2352 by 1568 pixels — 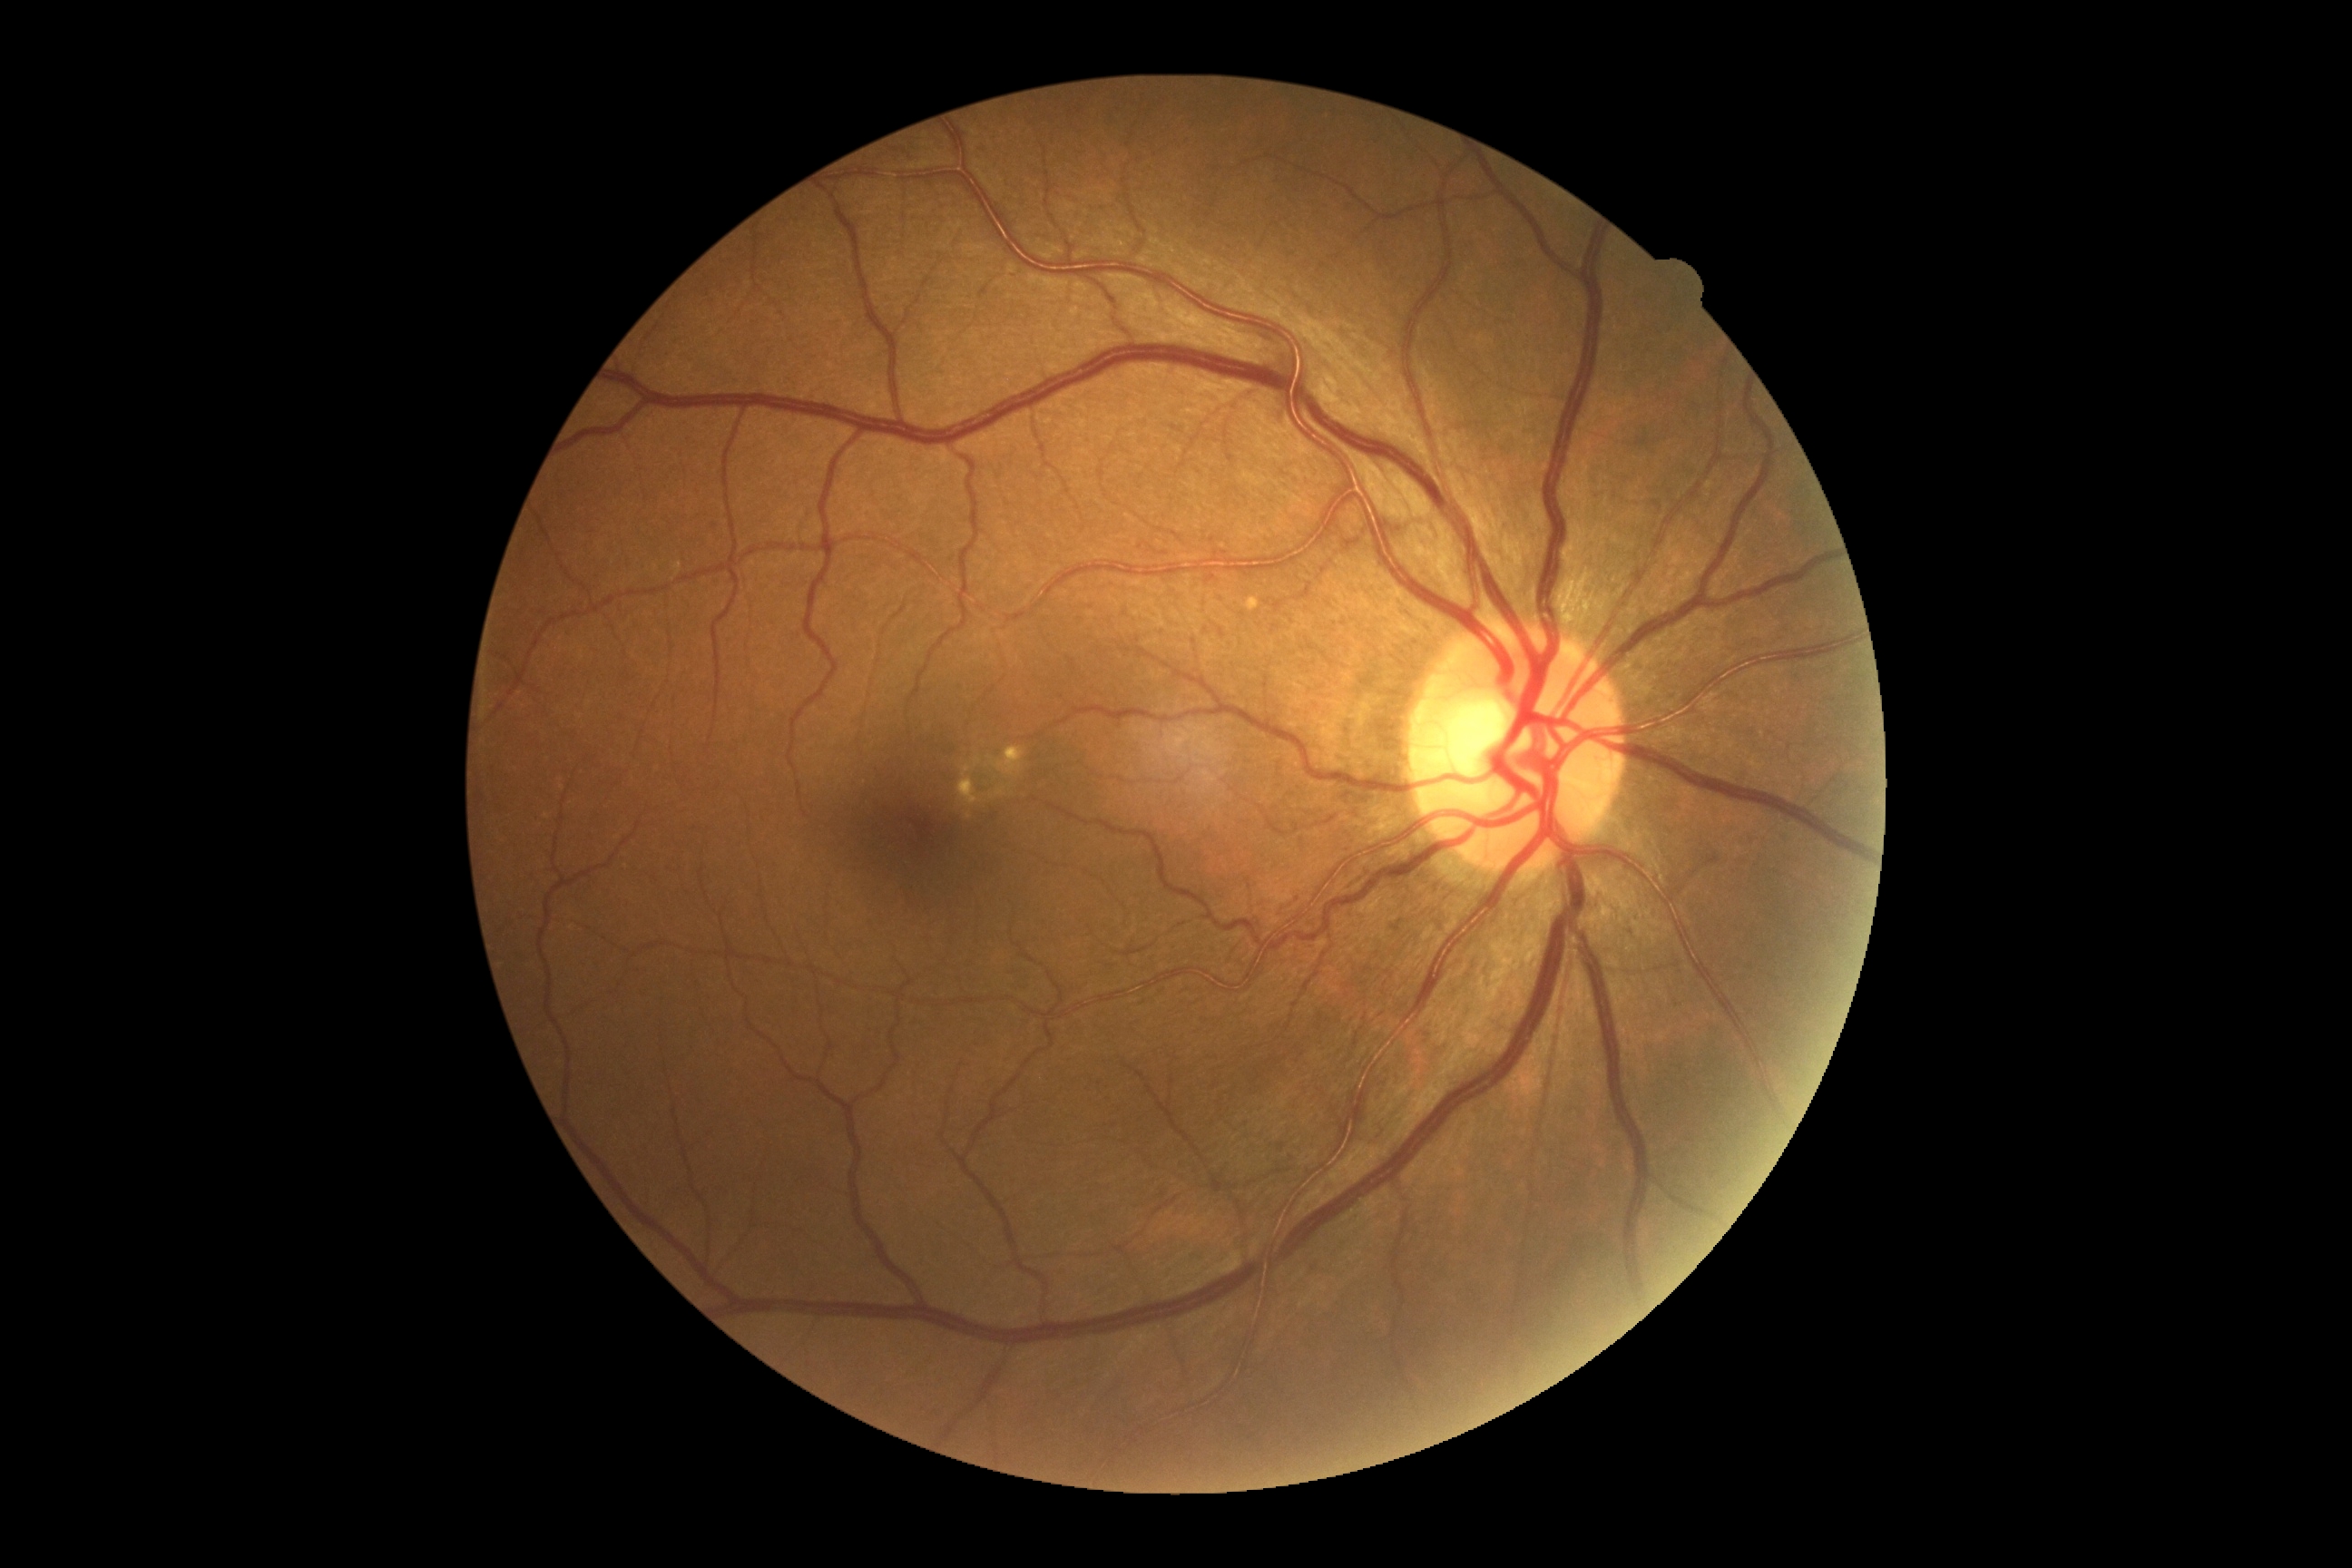 diabetic retinopathy grade: 0 | DR impression: no apparent DR.